1440 x 1080 pixels; wide-field contact fundus photograph of an infant; camera: Natus RetCam Envision (130° FOV):
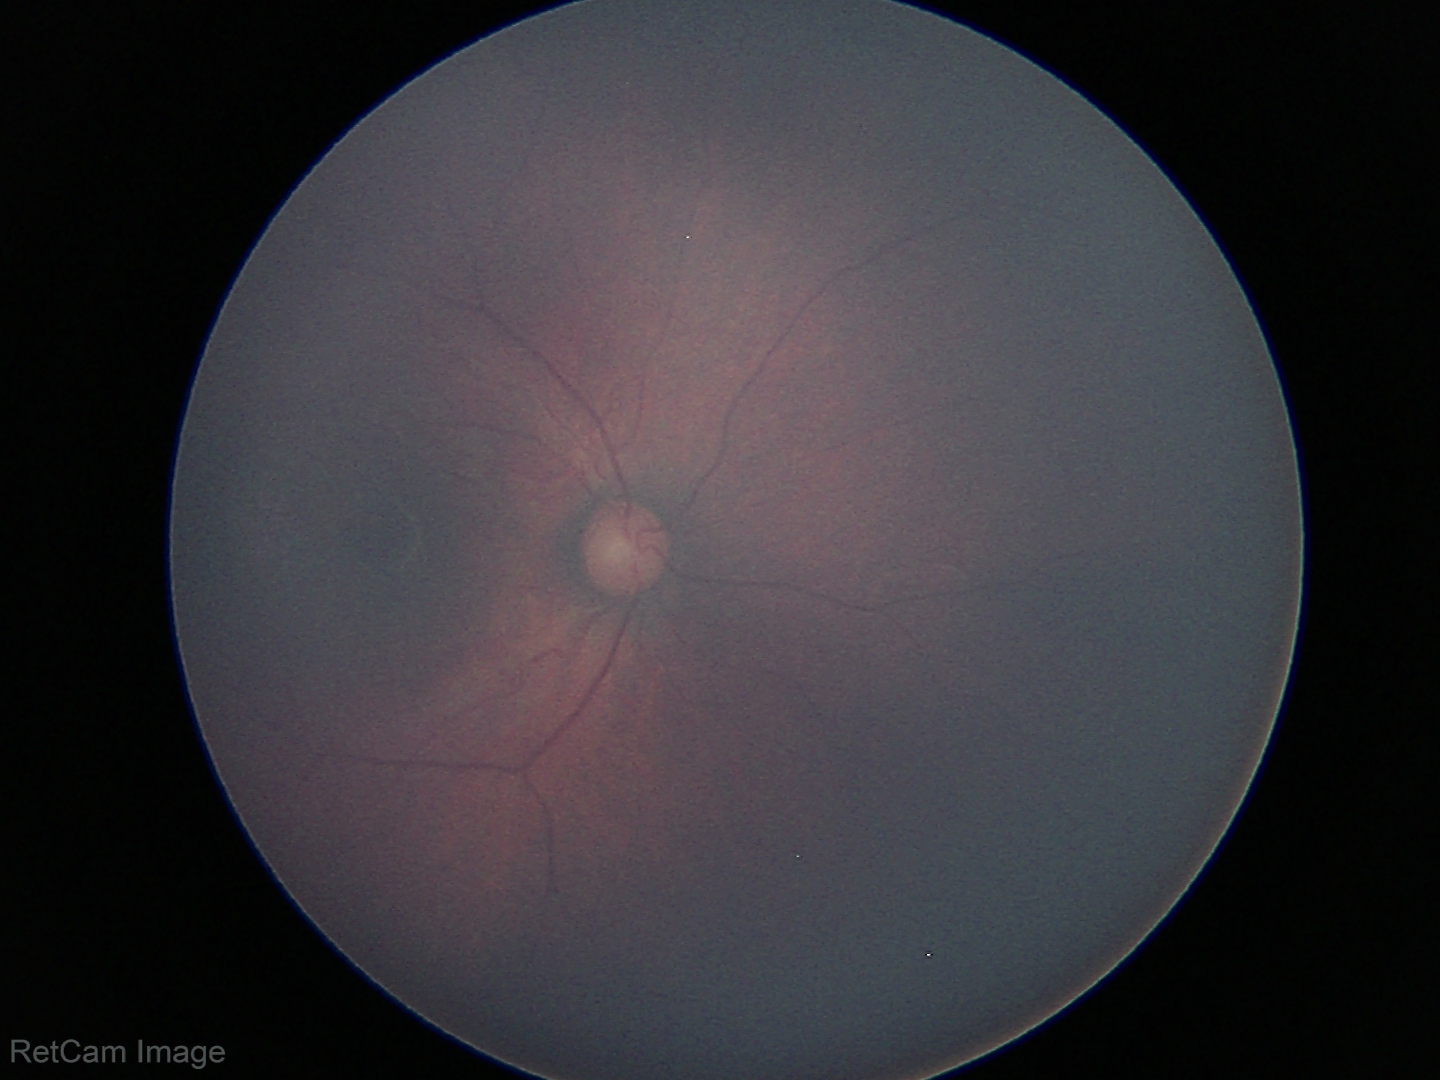 Screening examination with no abnormal retinal findings.